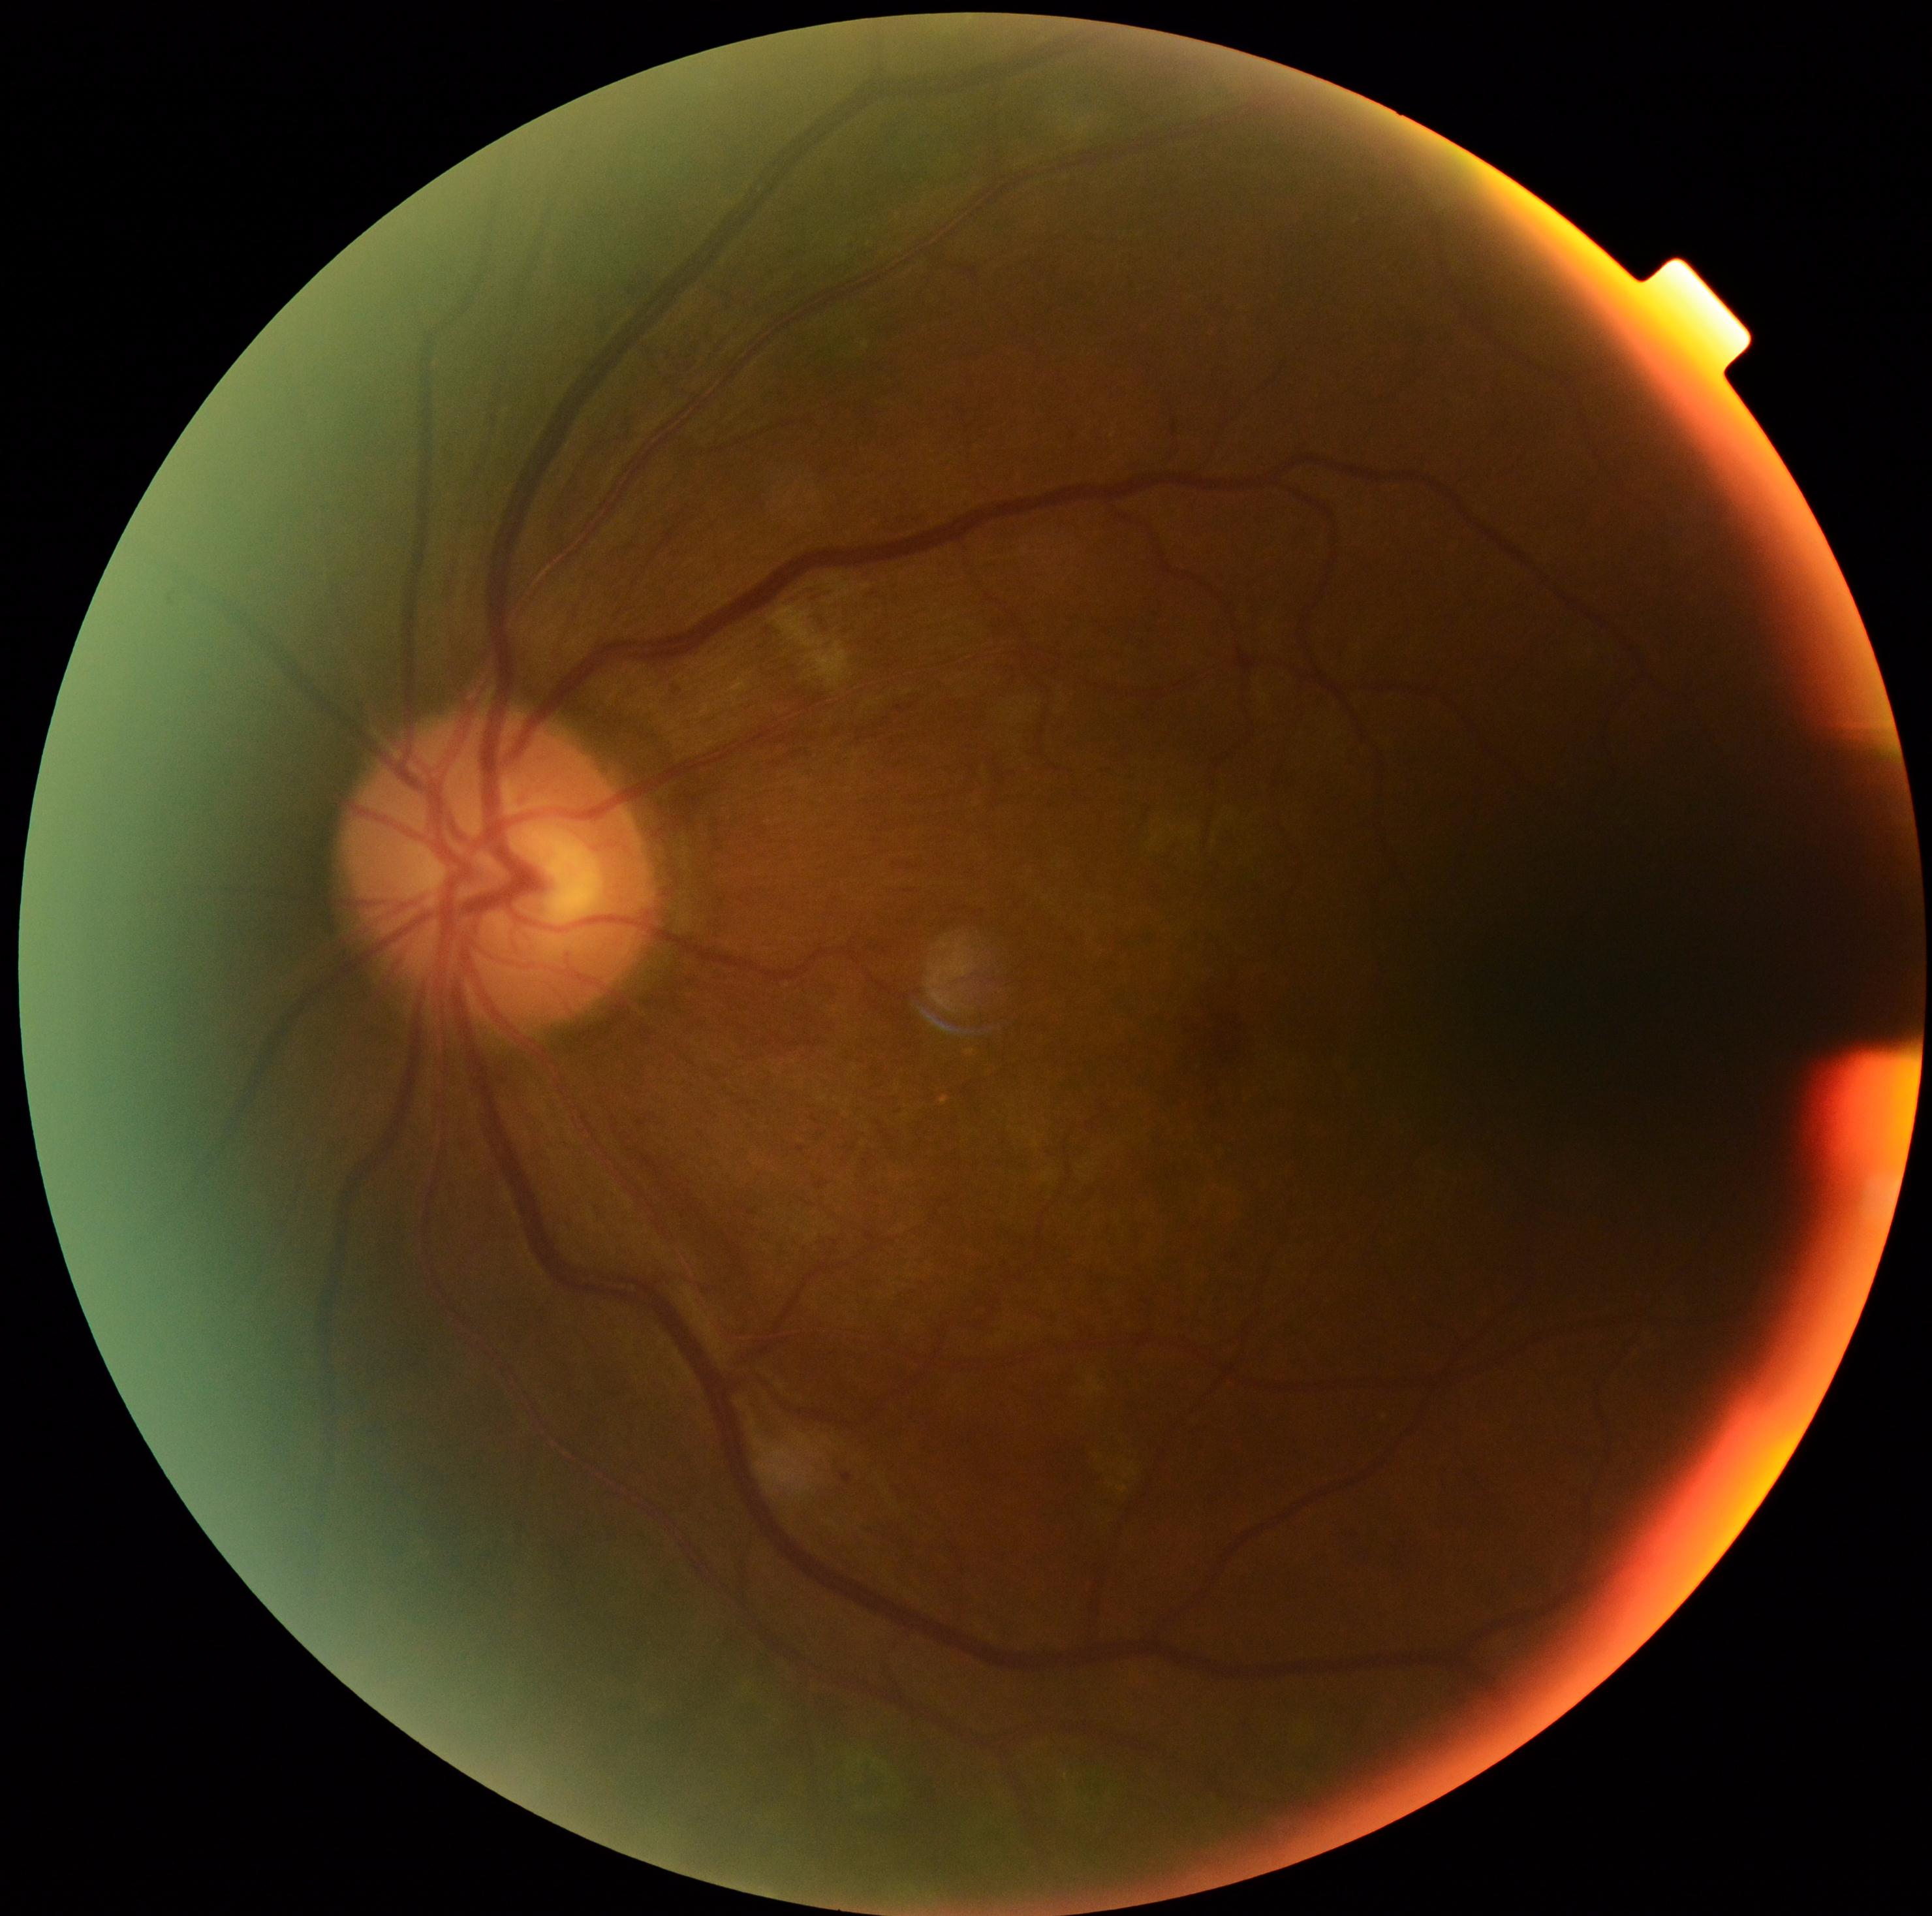

The retinopathy is classified as non-proliferative diabetic retinopathy. DR severity: 2.